NIDEK AFC-230 fundus camera.
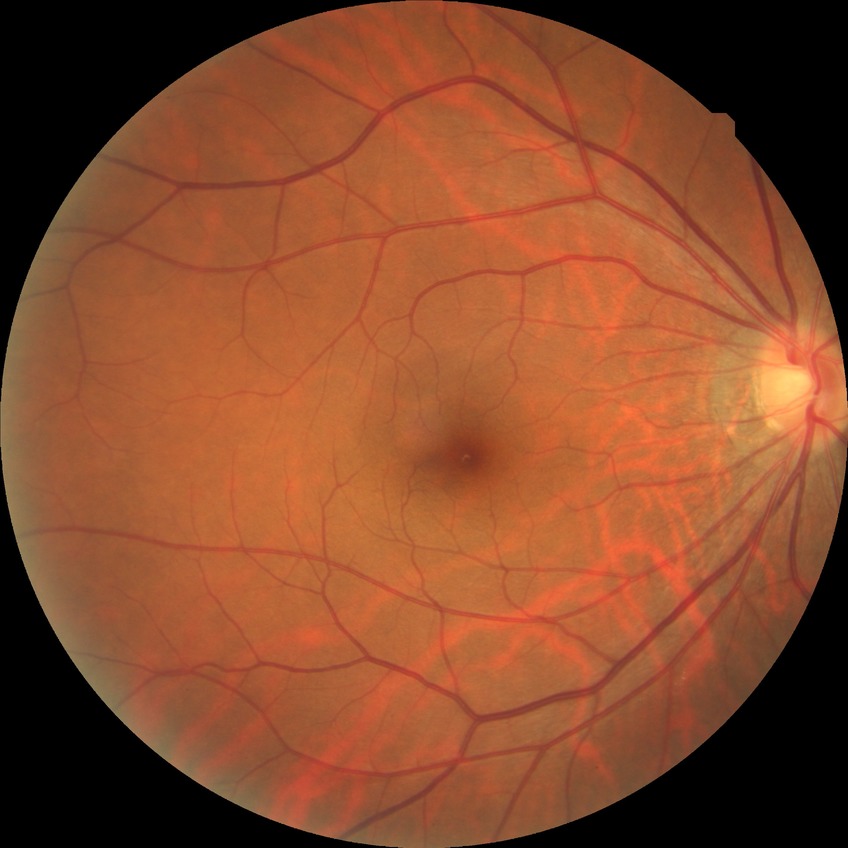 diabetic retinopathy severity = no diabetic retinopathy.